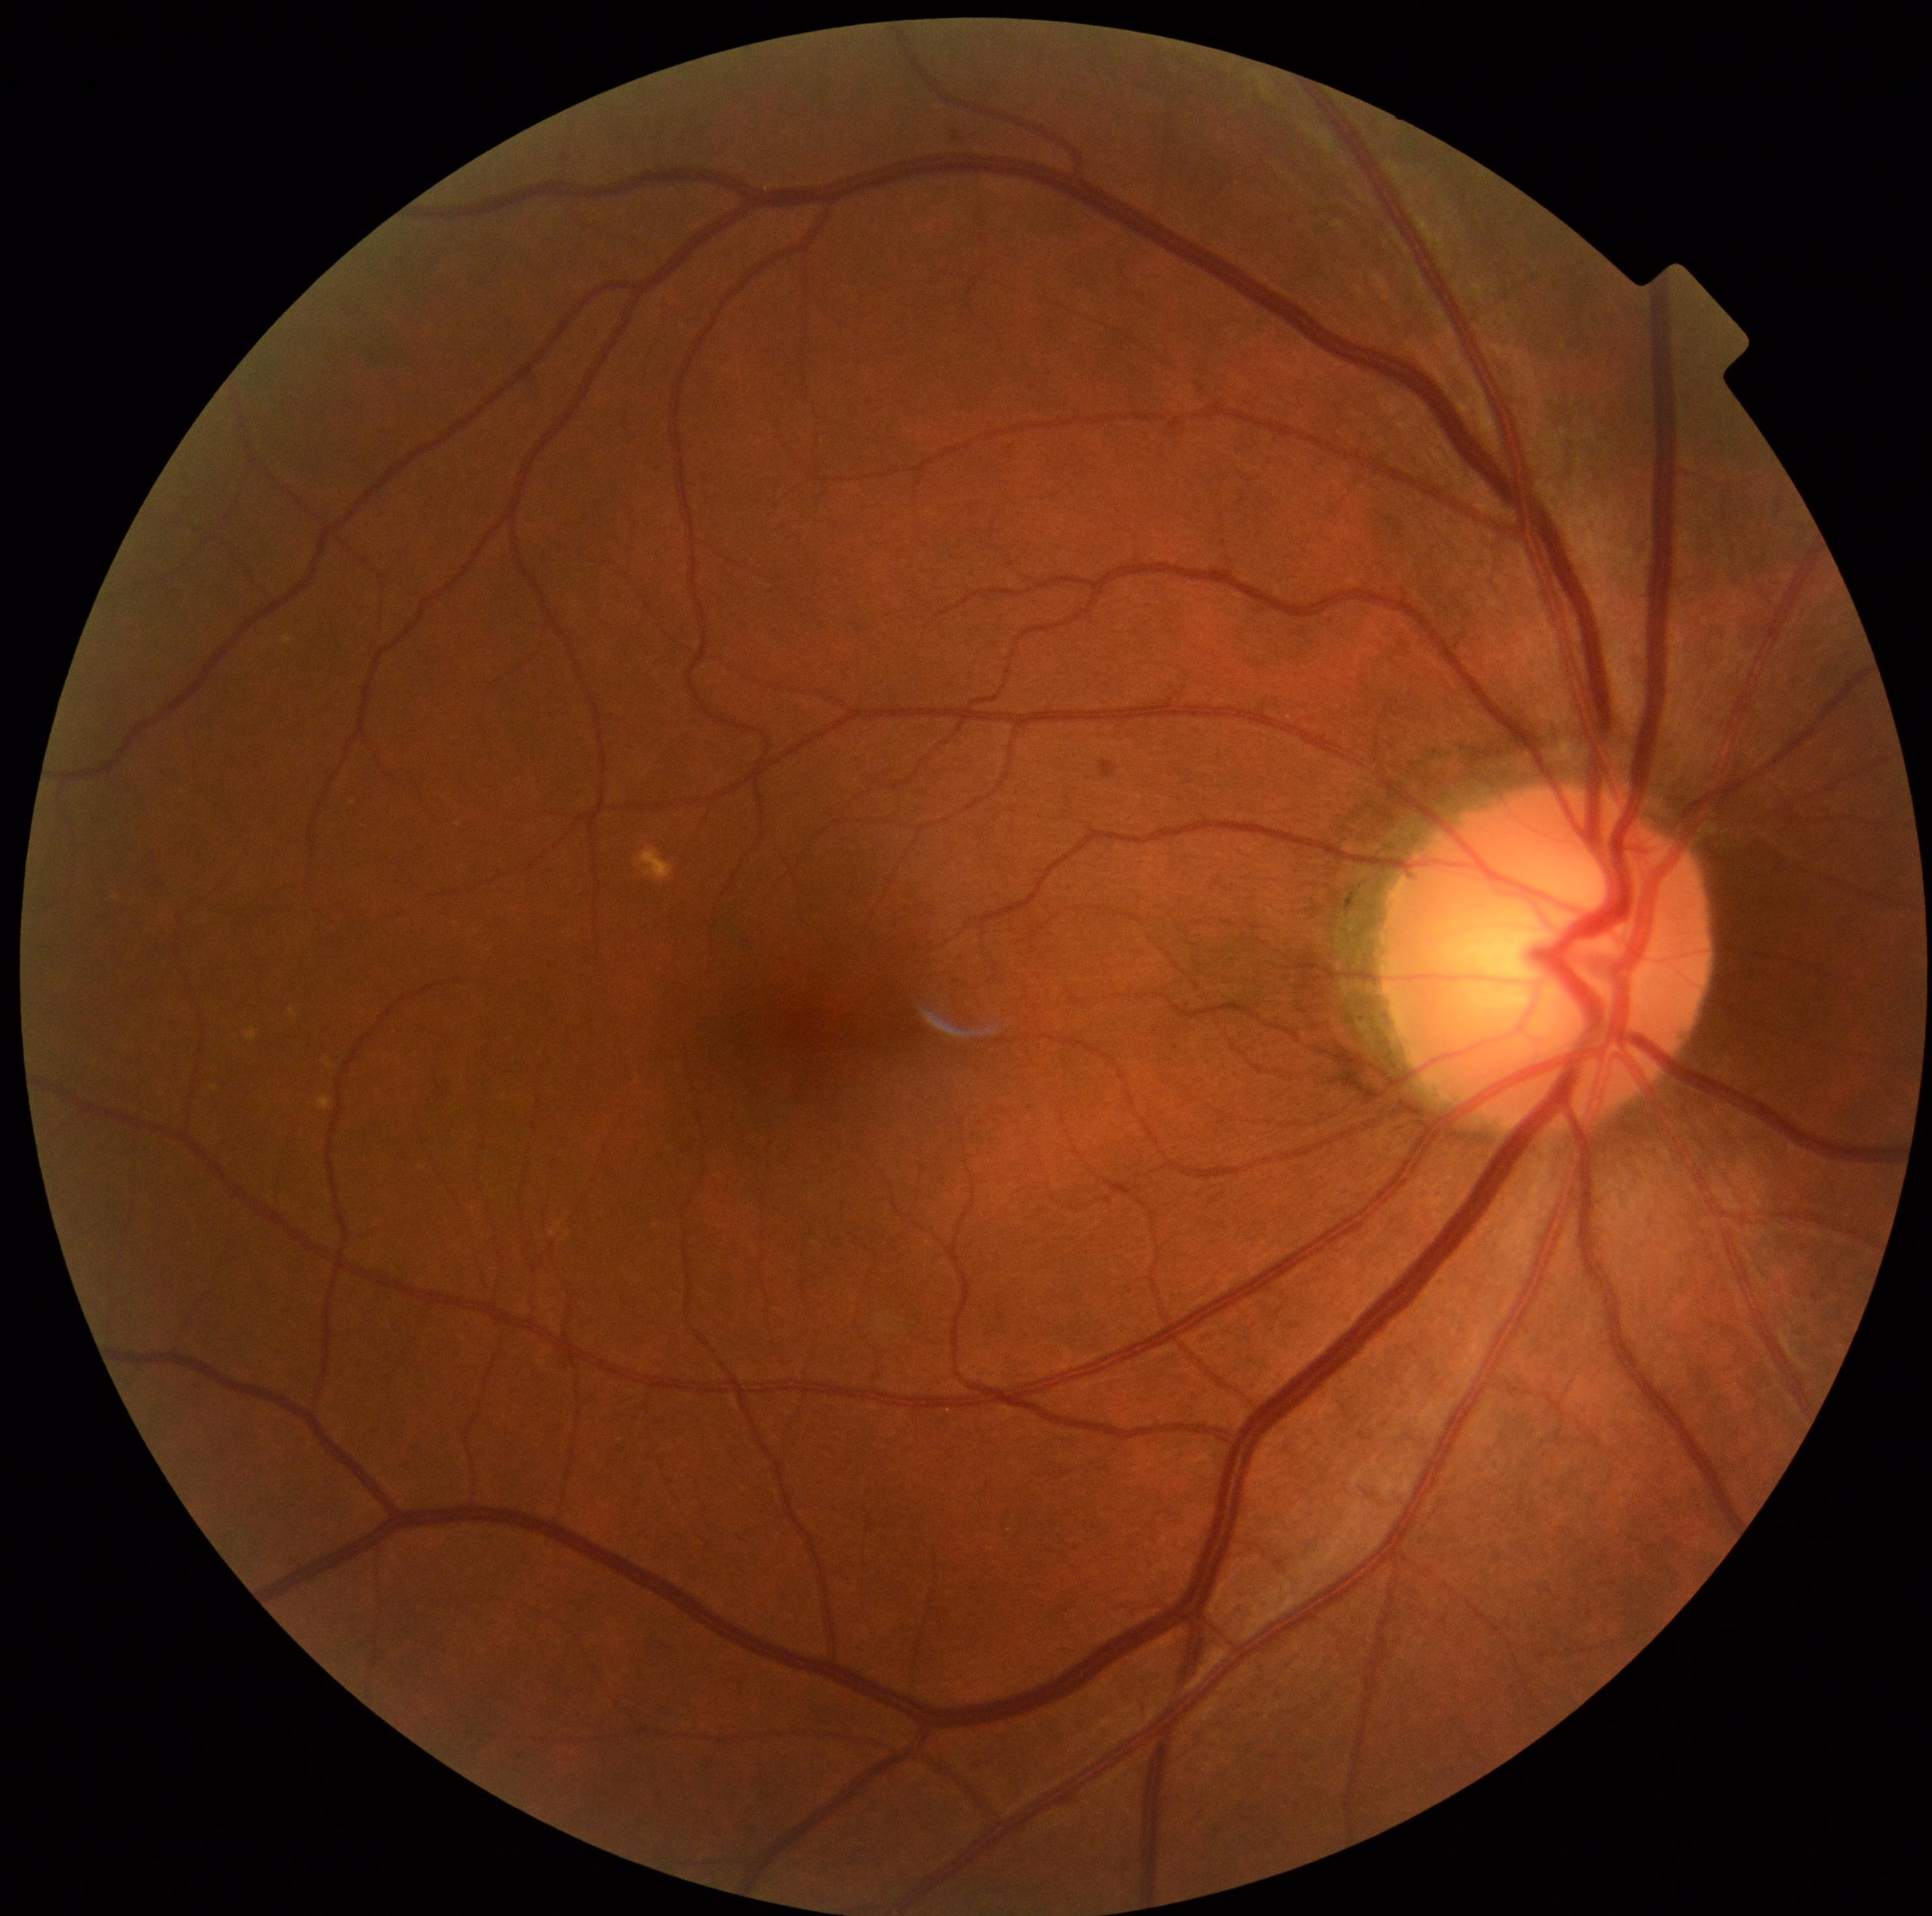 retinopathy grade@0/4.